Pediatric retinal photograph (wide-field) — 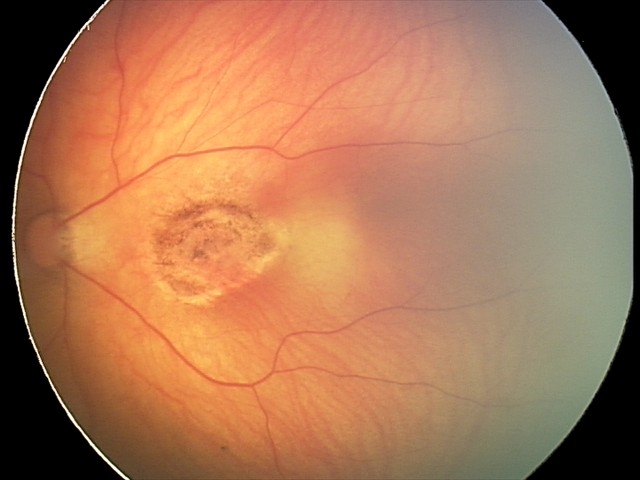 From an examination with diagnosis of toxoplasmosis chorioretinitis.